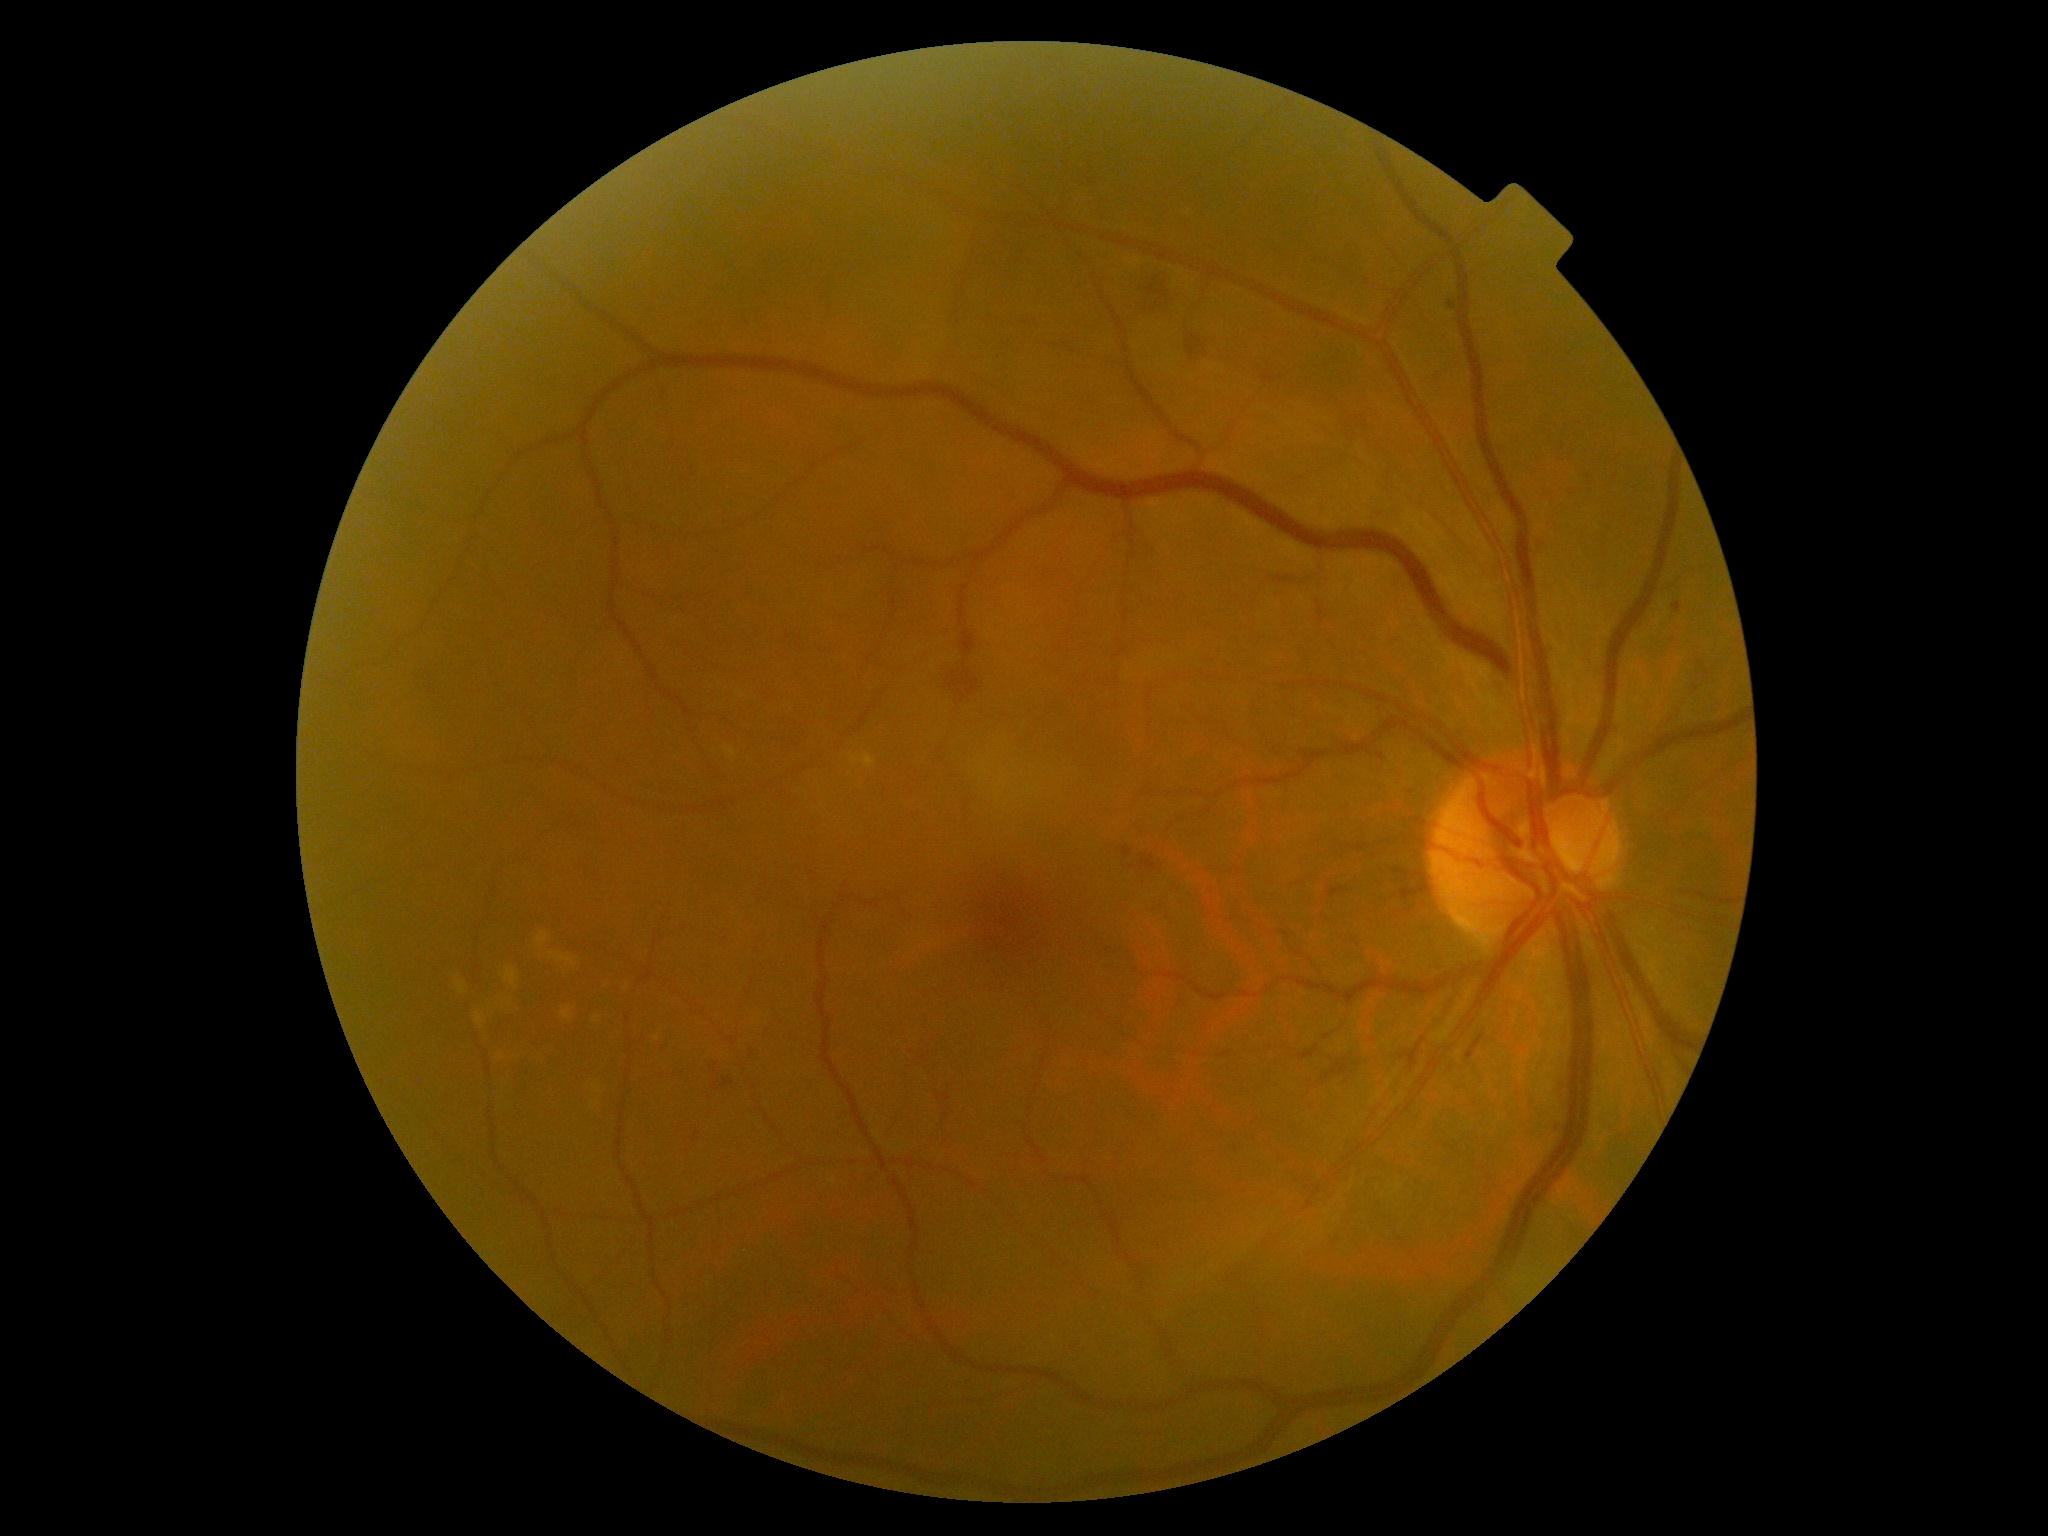
diabetic retinopathy: moderate non-proliferative diabetic retinopathy (grade 2), DR class: non-proliferative diabetic retinopathy.